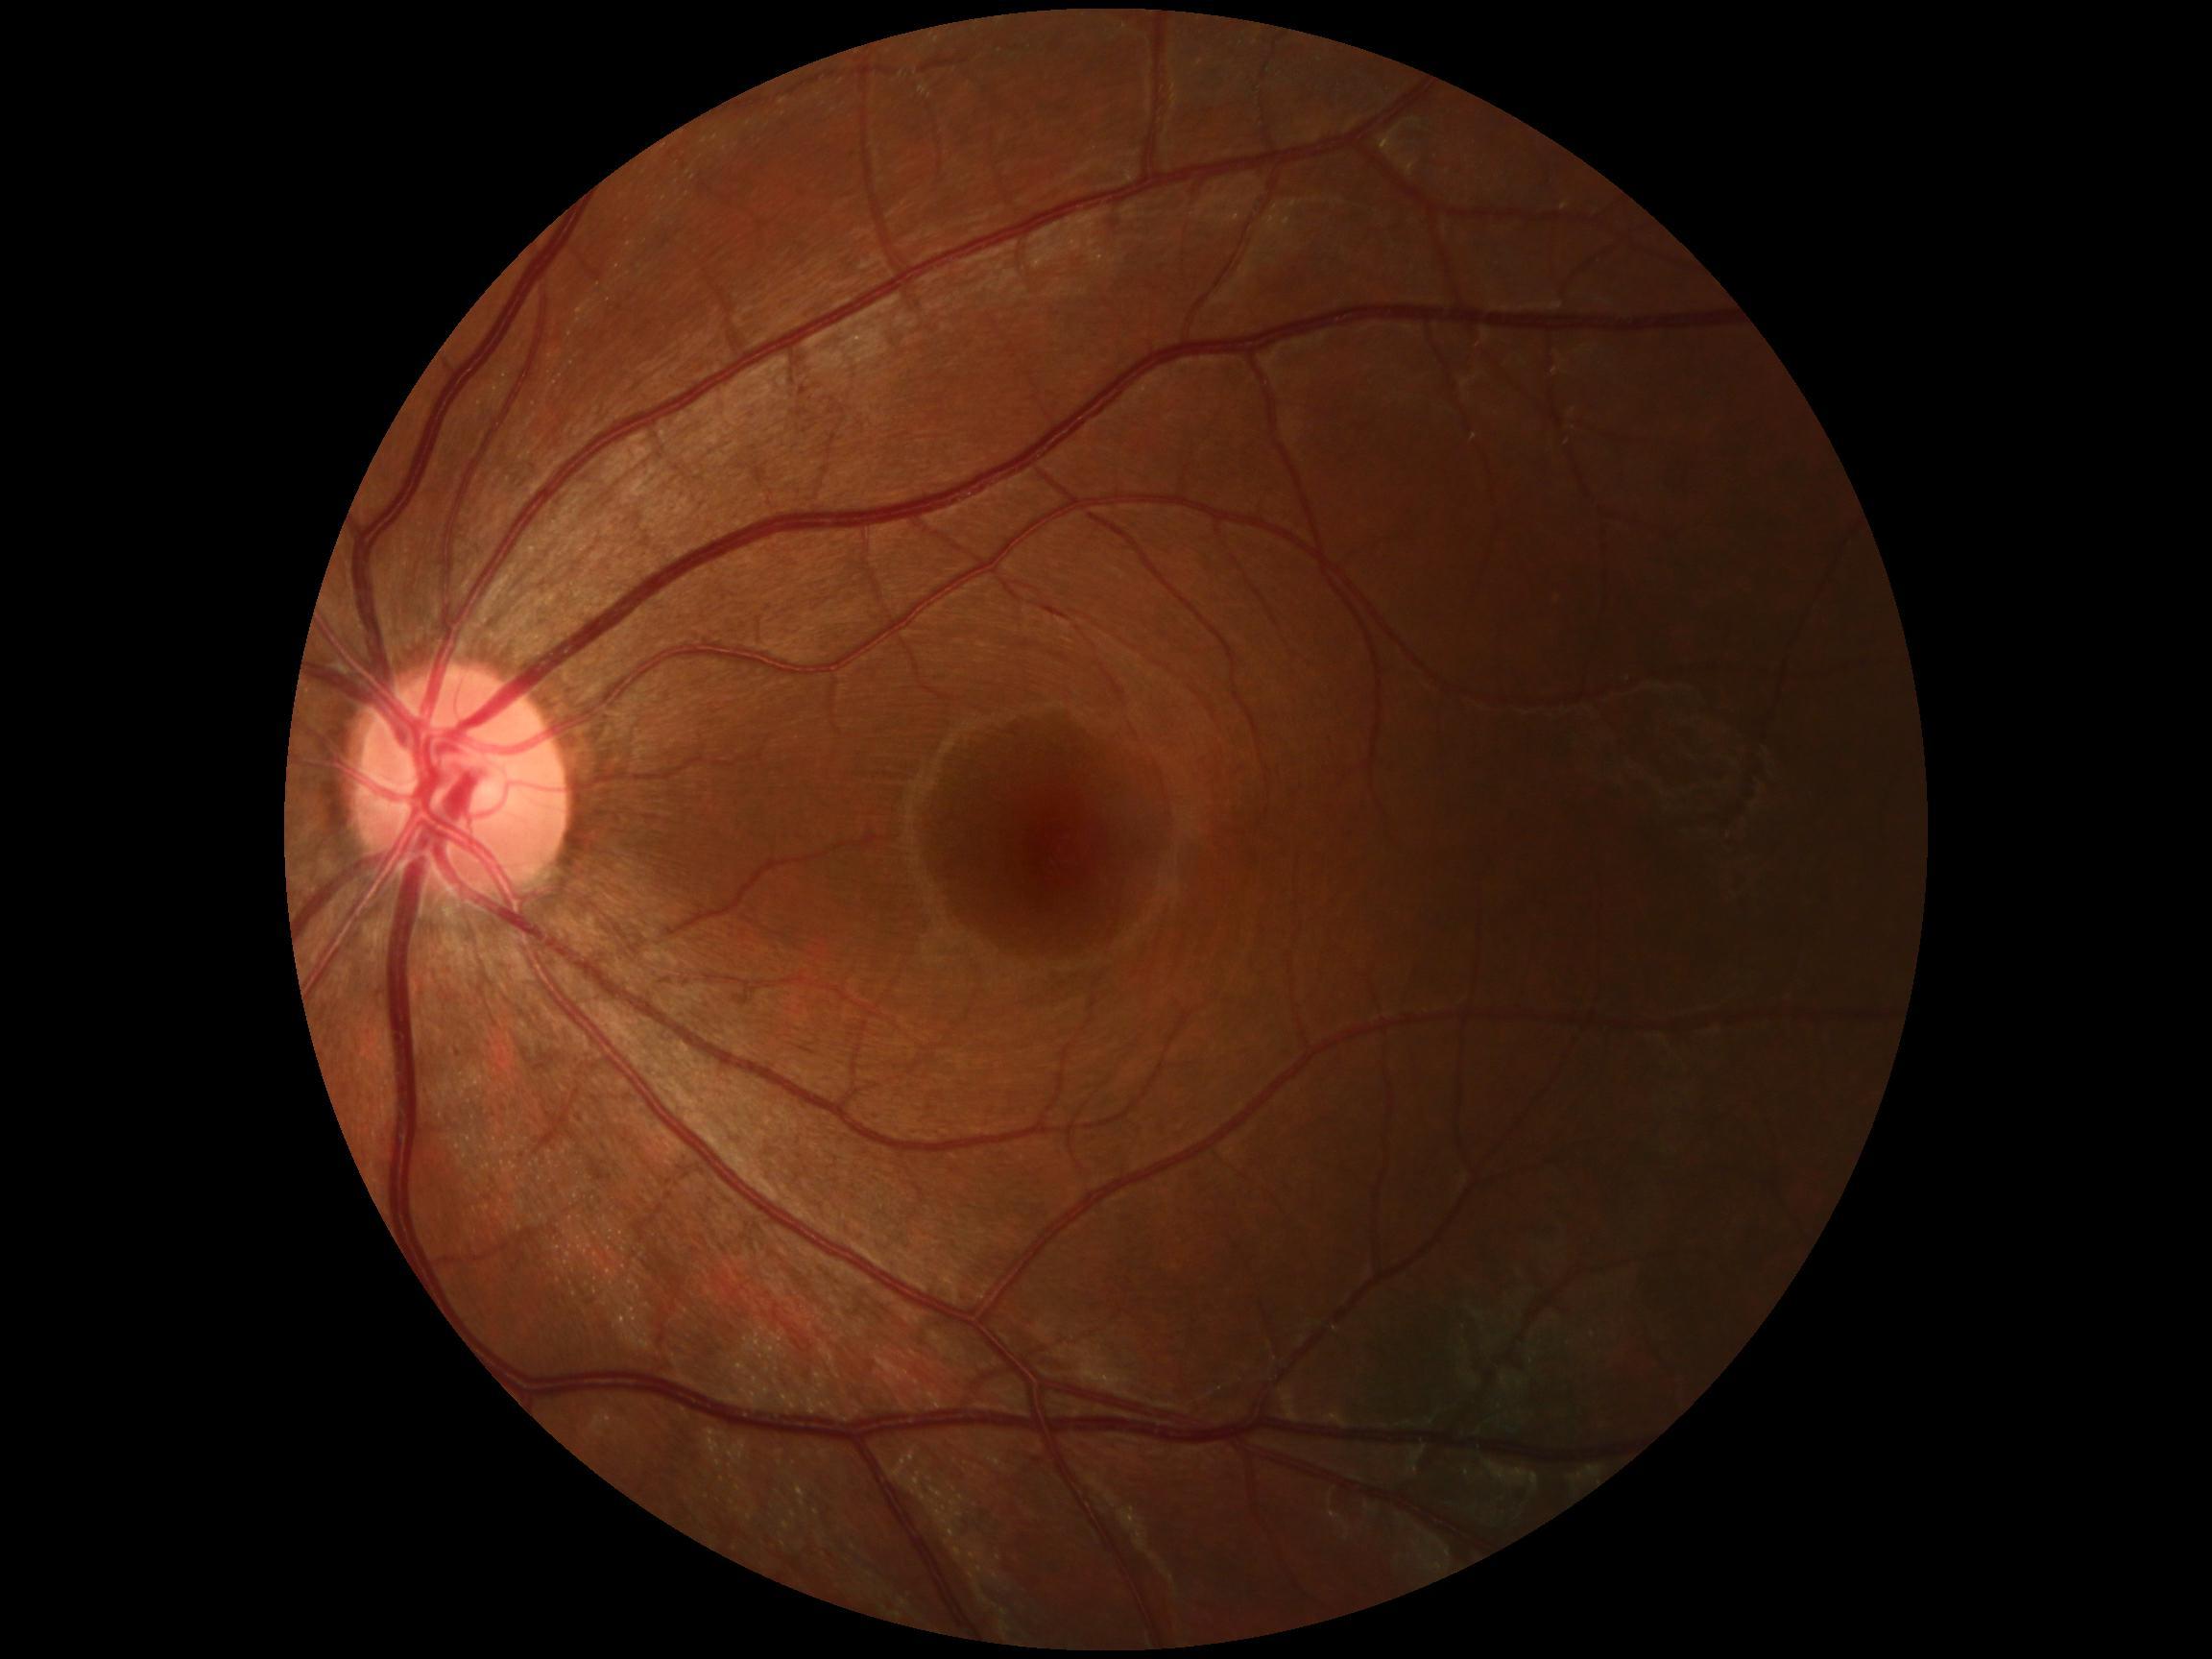
DR: grade 0 (no apparent retinopathy) — no visible signs of diabetic retinopathy.